1932 by 1910 pixels, 45° FOV
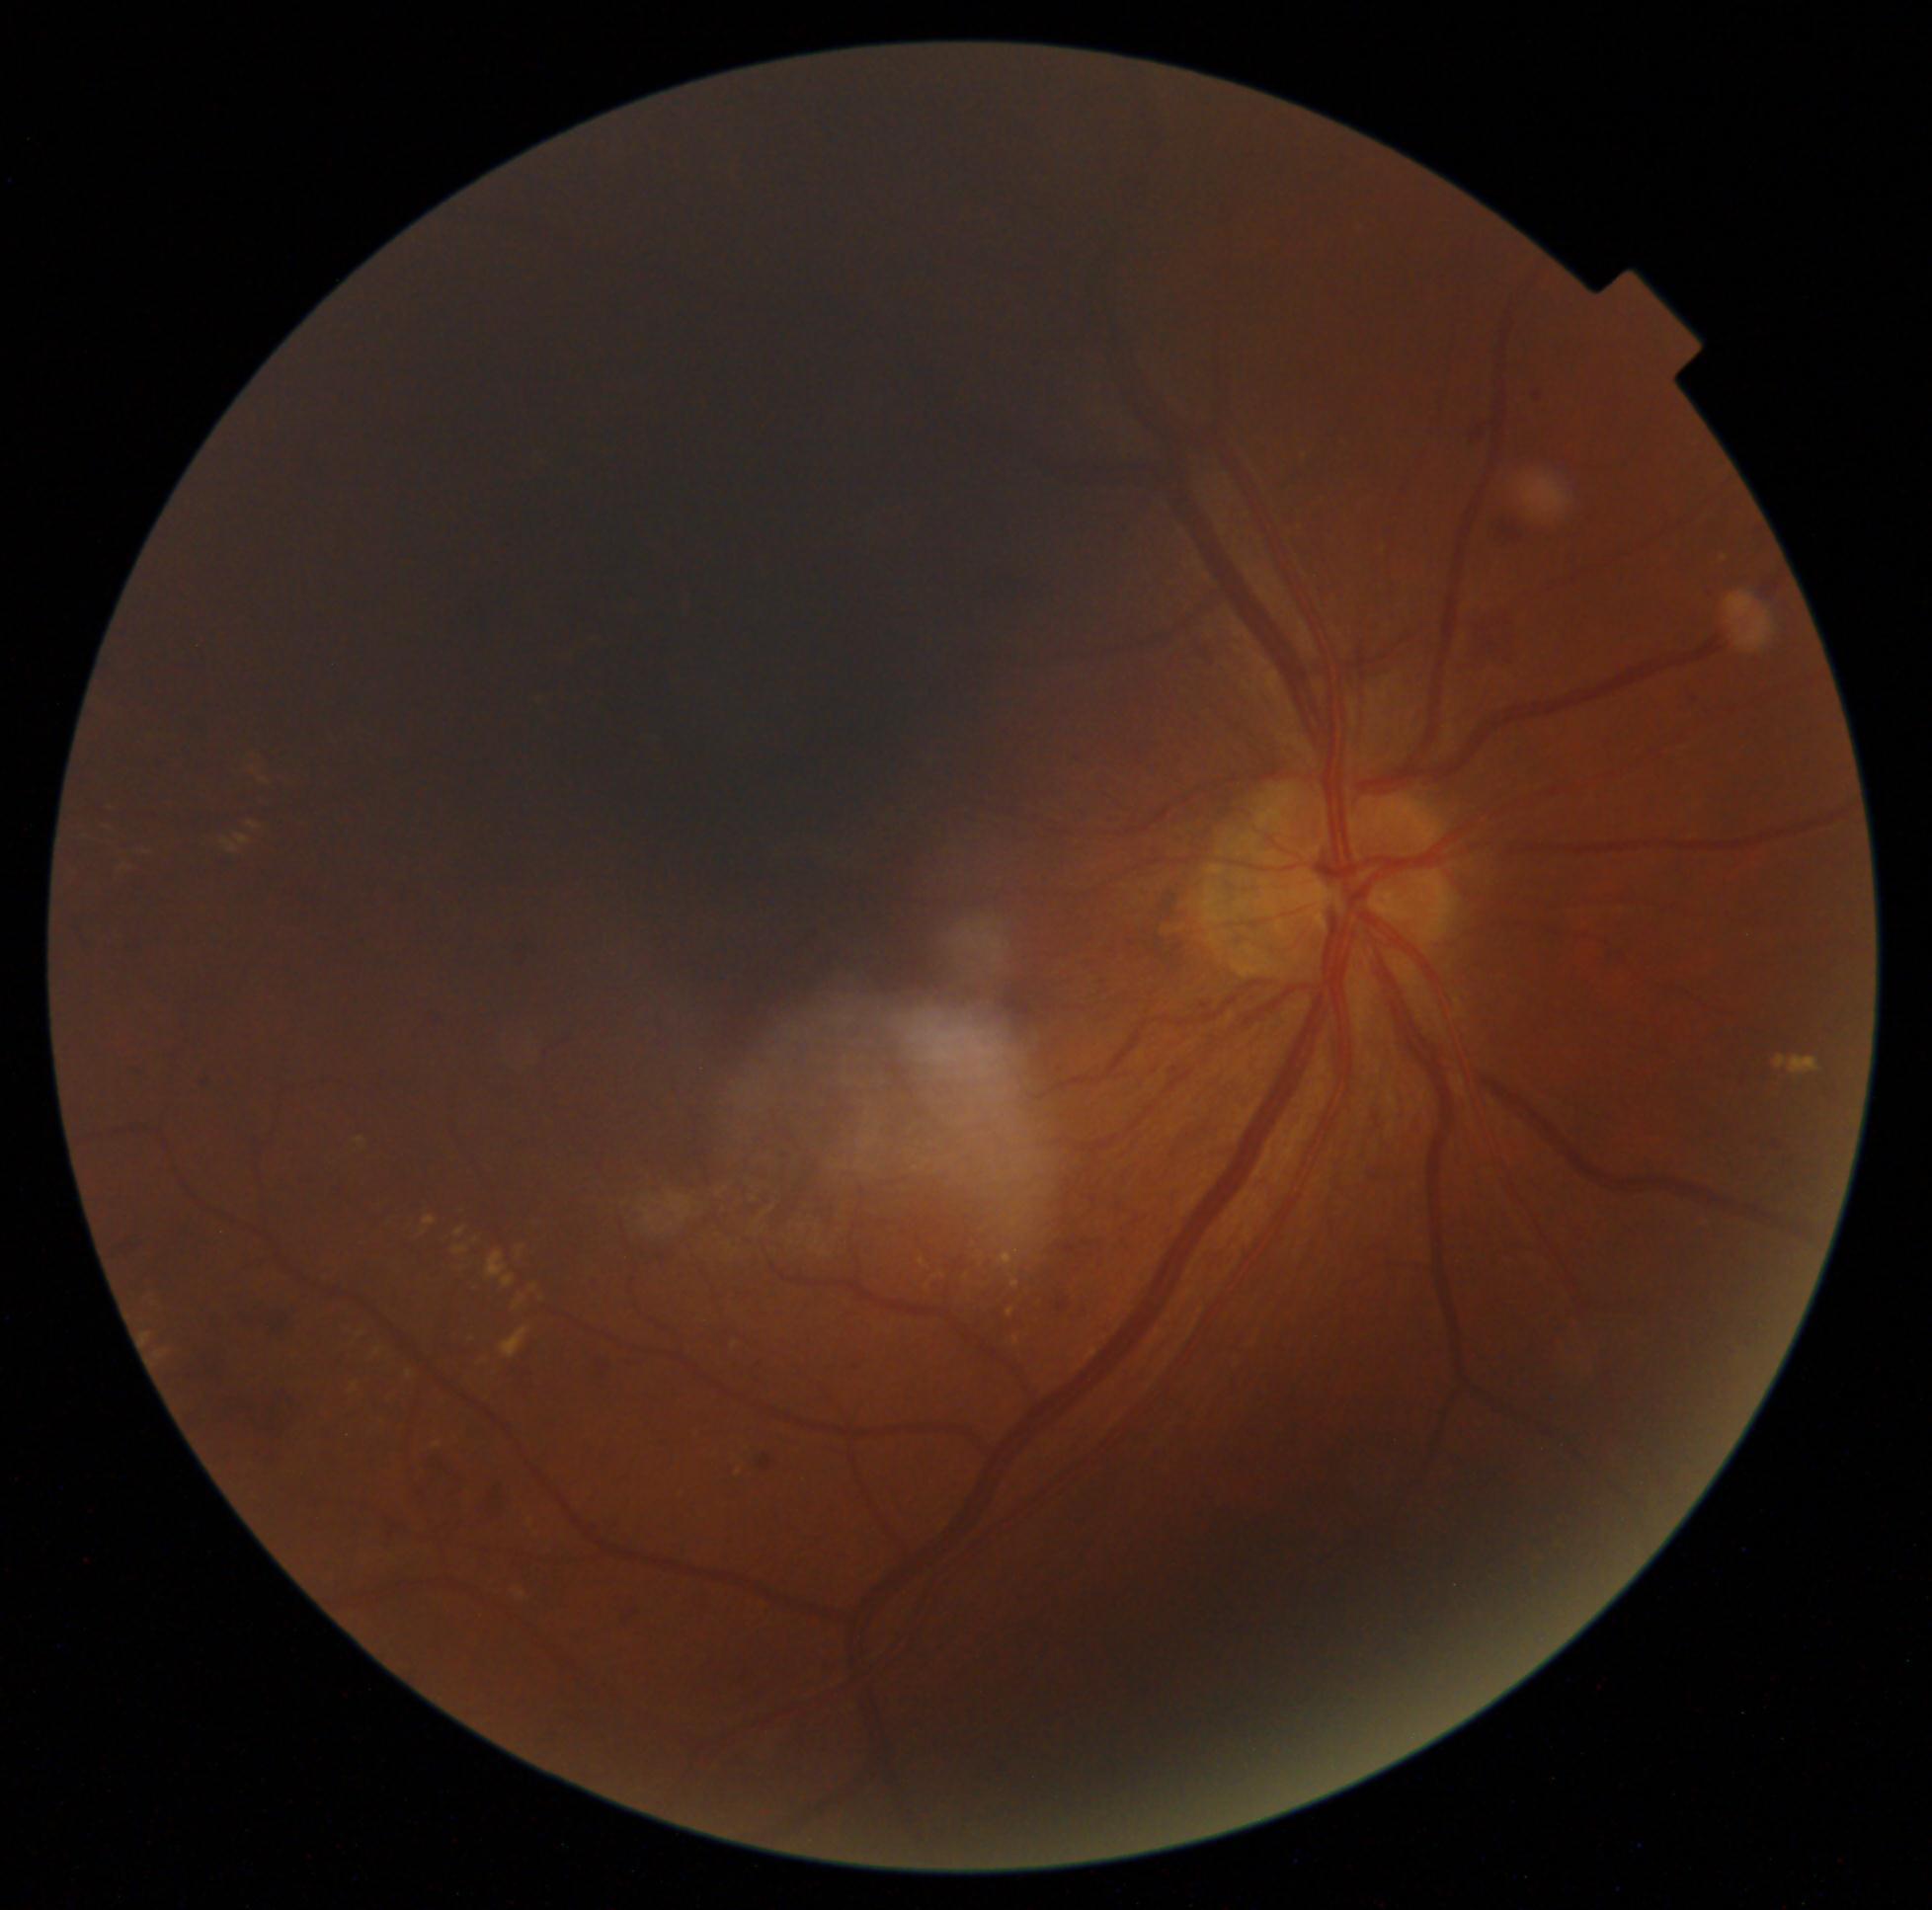 diabetic retinopathy (DR) = grade 2 (moderate NPDR) — more than just microaneurysms but less than severe NPDR.